Infant wide-field retinal image. Captured with the Clarity RetCam 3 (130° field of view)
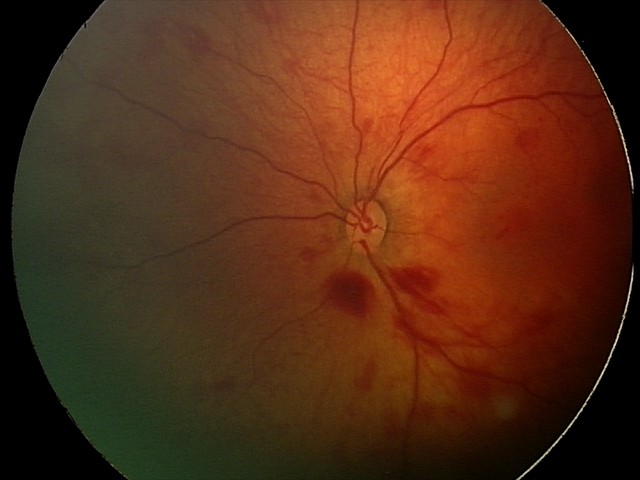

Screening diagnosis: retinal hemorrhages.